Wide-field fundus photograph from neonatal ROP screening · 130° field of view (Clarity RetCam 3): 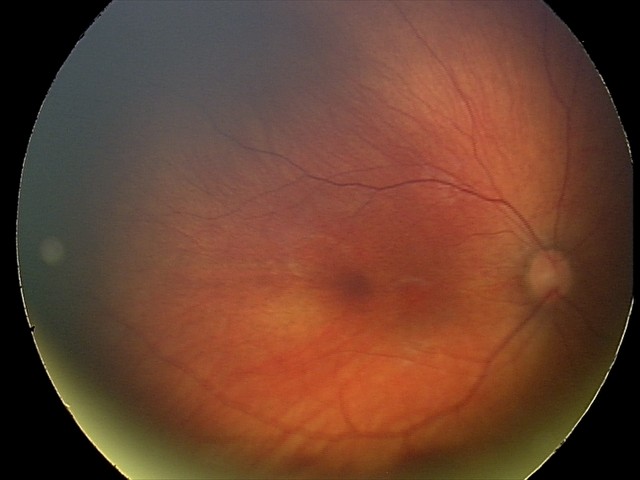

Series diagnosed as retinal hemorrhages.